848 by 848 pixels, nonmydriatic fundus photograph: 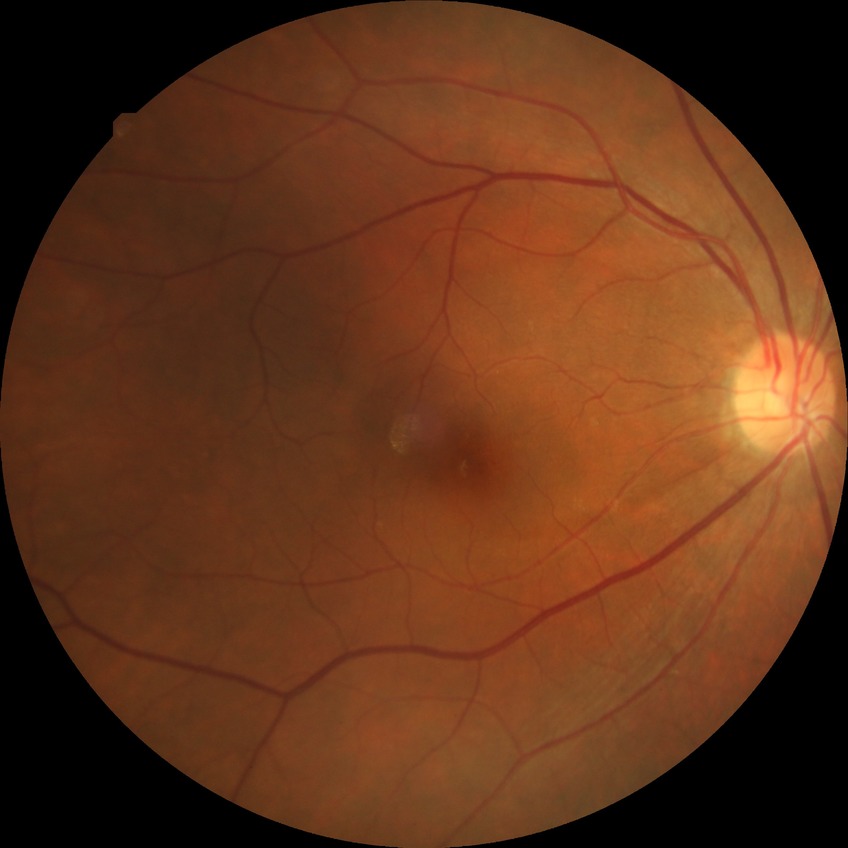

Diabetic retinopathy (DR): NDR (no diabetic retinopathy).